2352x1568 · 45° FOV:
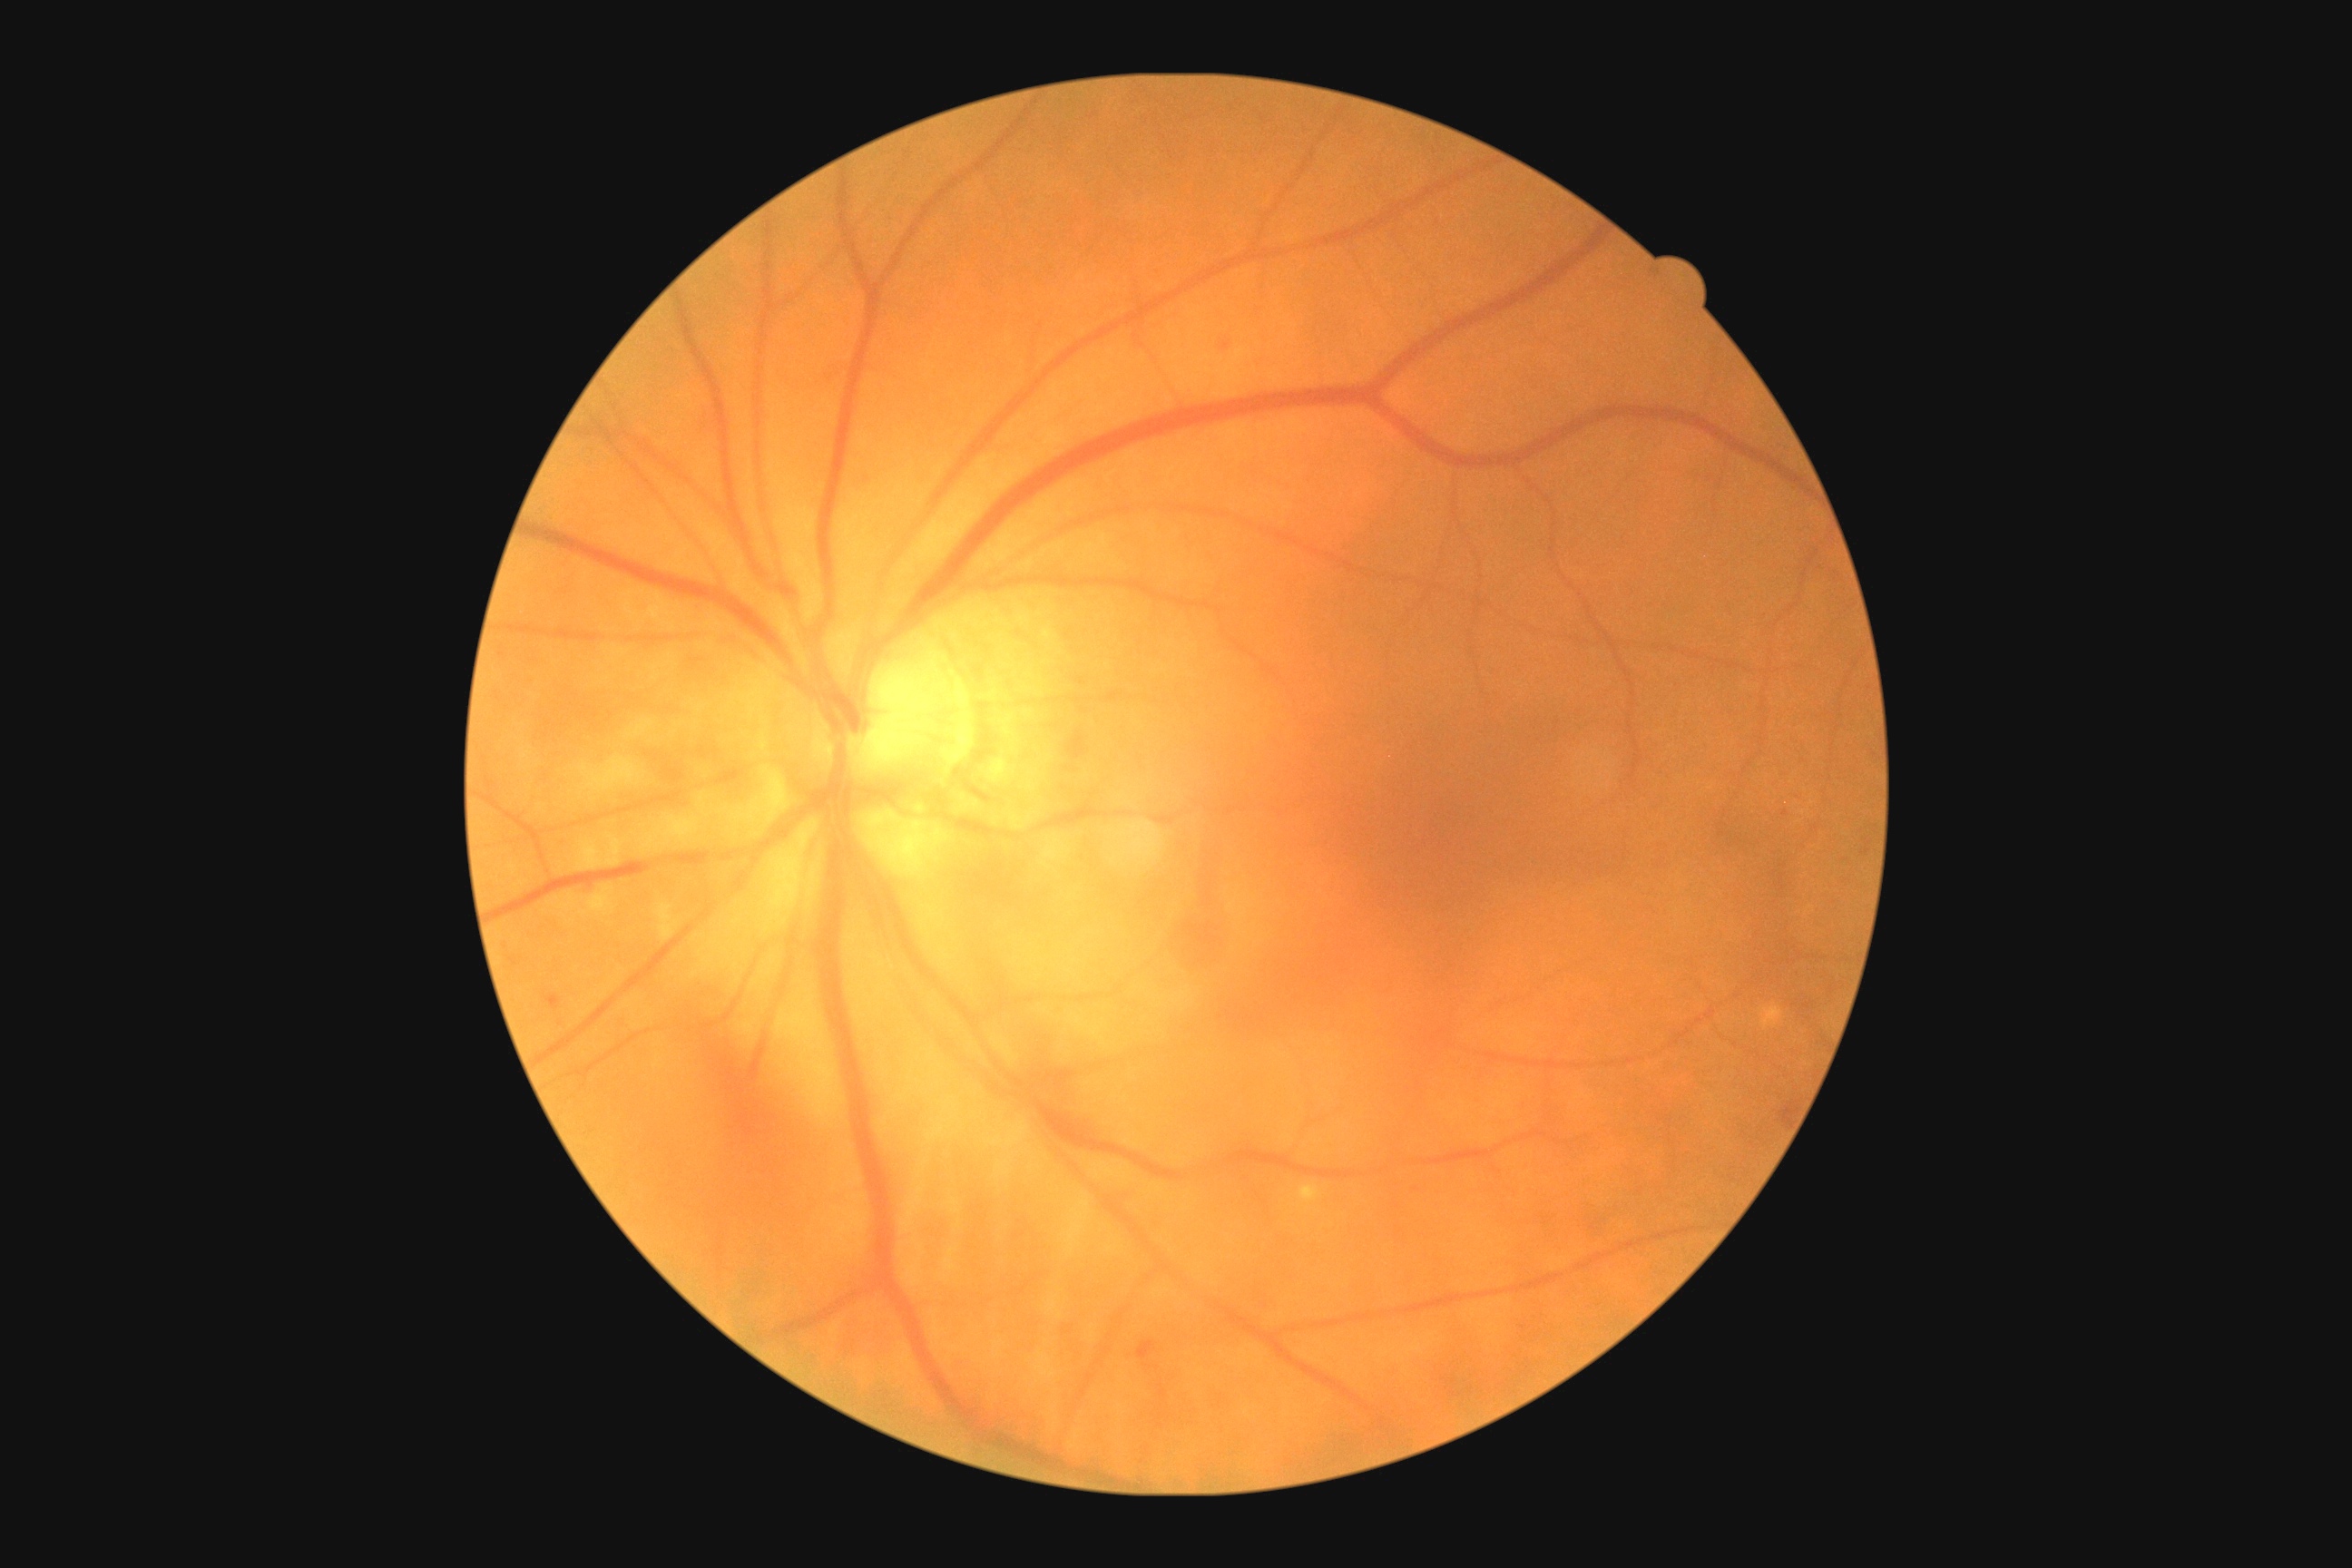
- retinopathy — moderate NPDR (grade 2) — more than just microaneurysms but less than severe NPDR